DR severity per modified Davis staging · retinal fundus photograph:
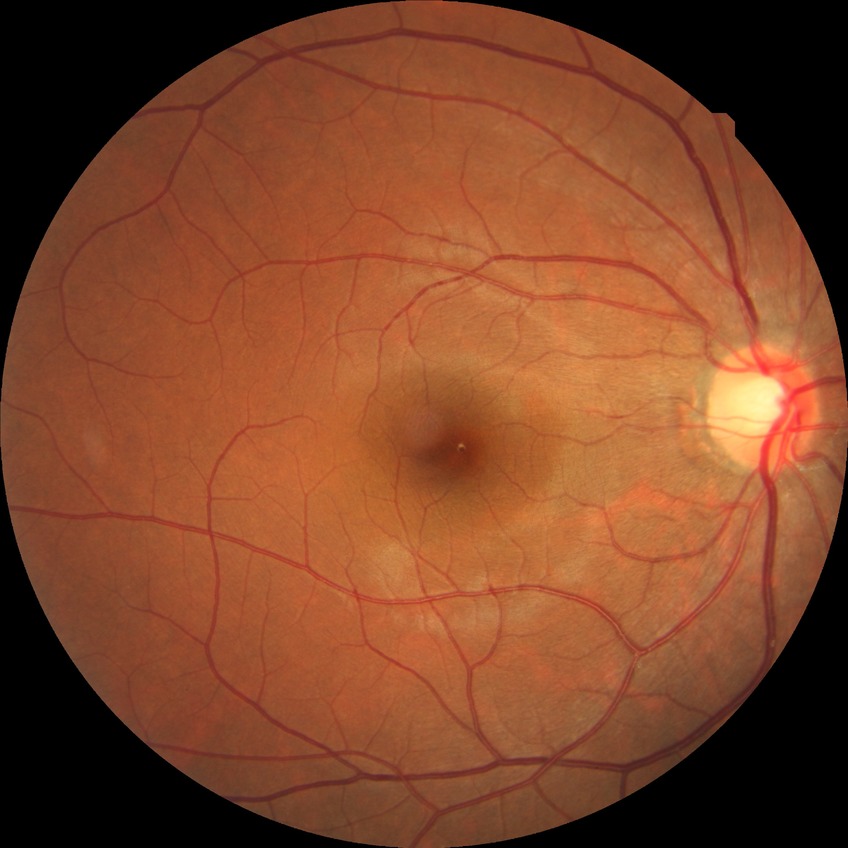 – diabetic retinopathy (DR) — no diabetic retinopathy (NDR)